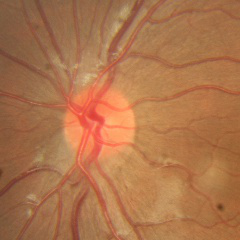 Fundus image with findings of no glaucoma.